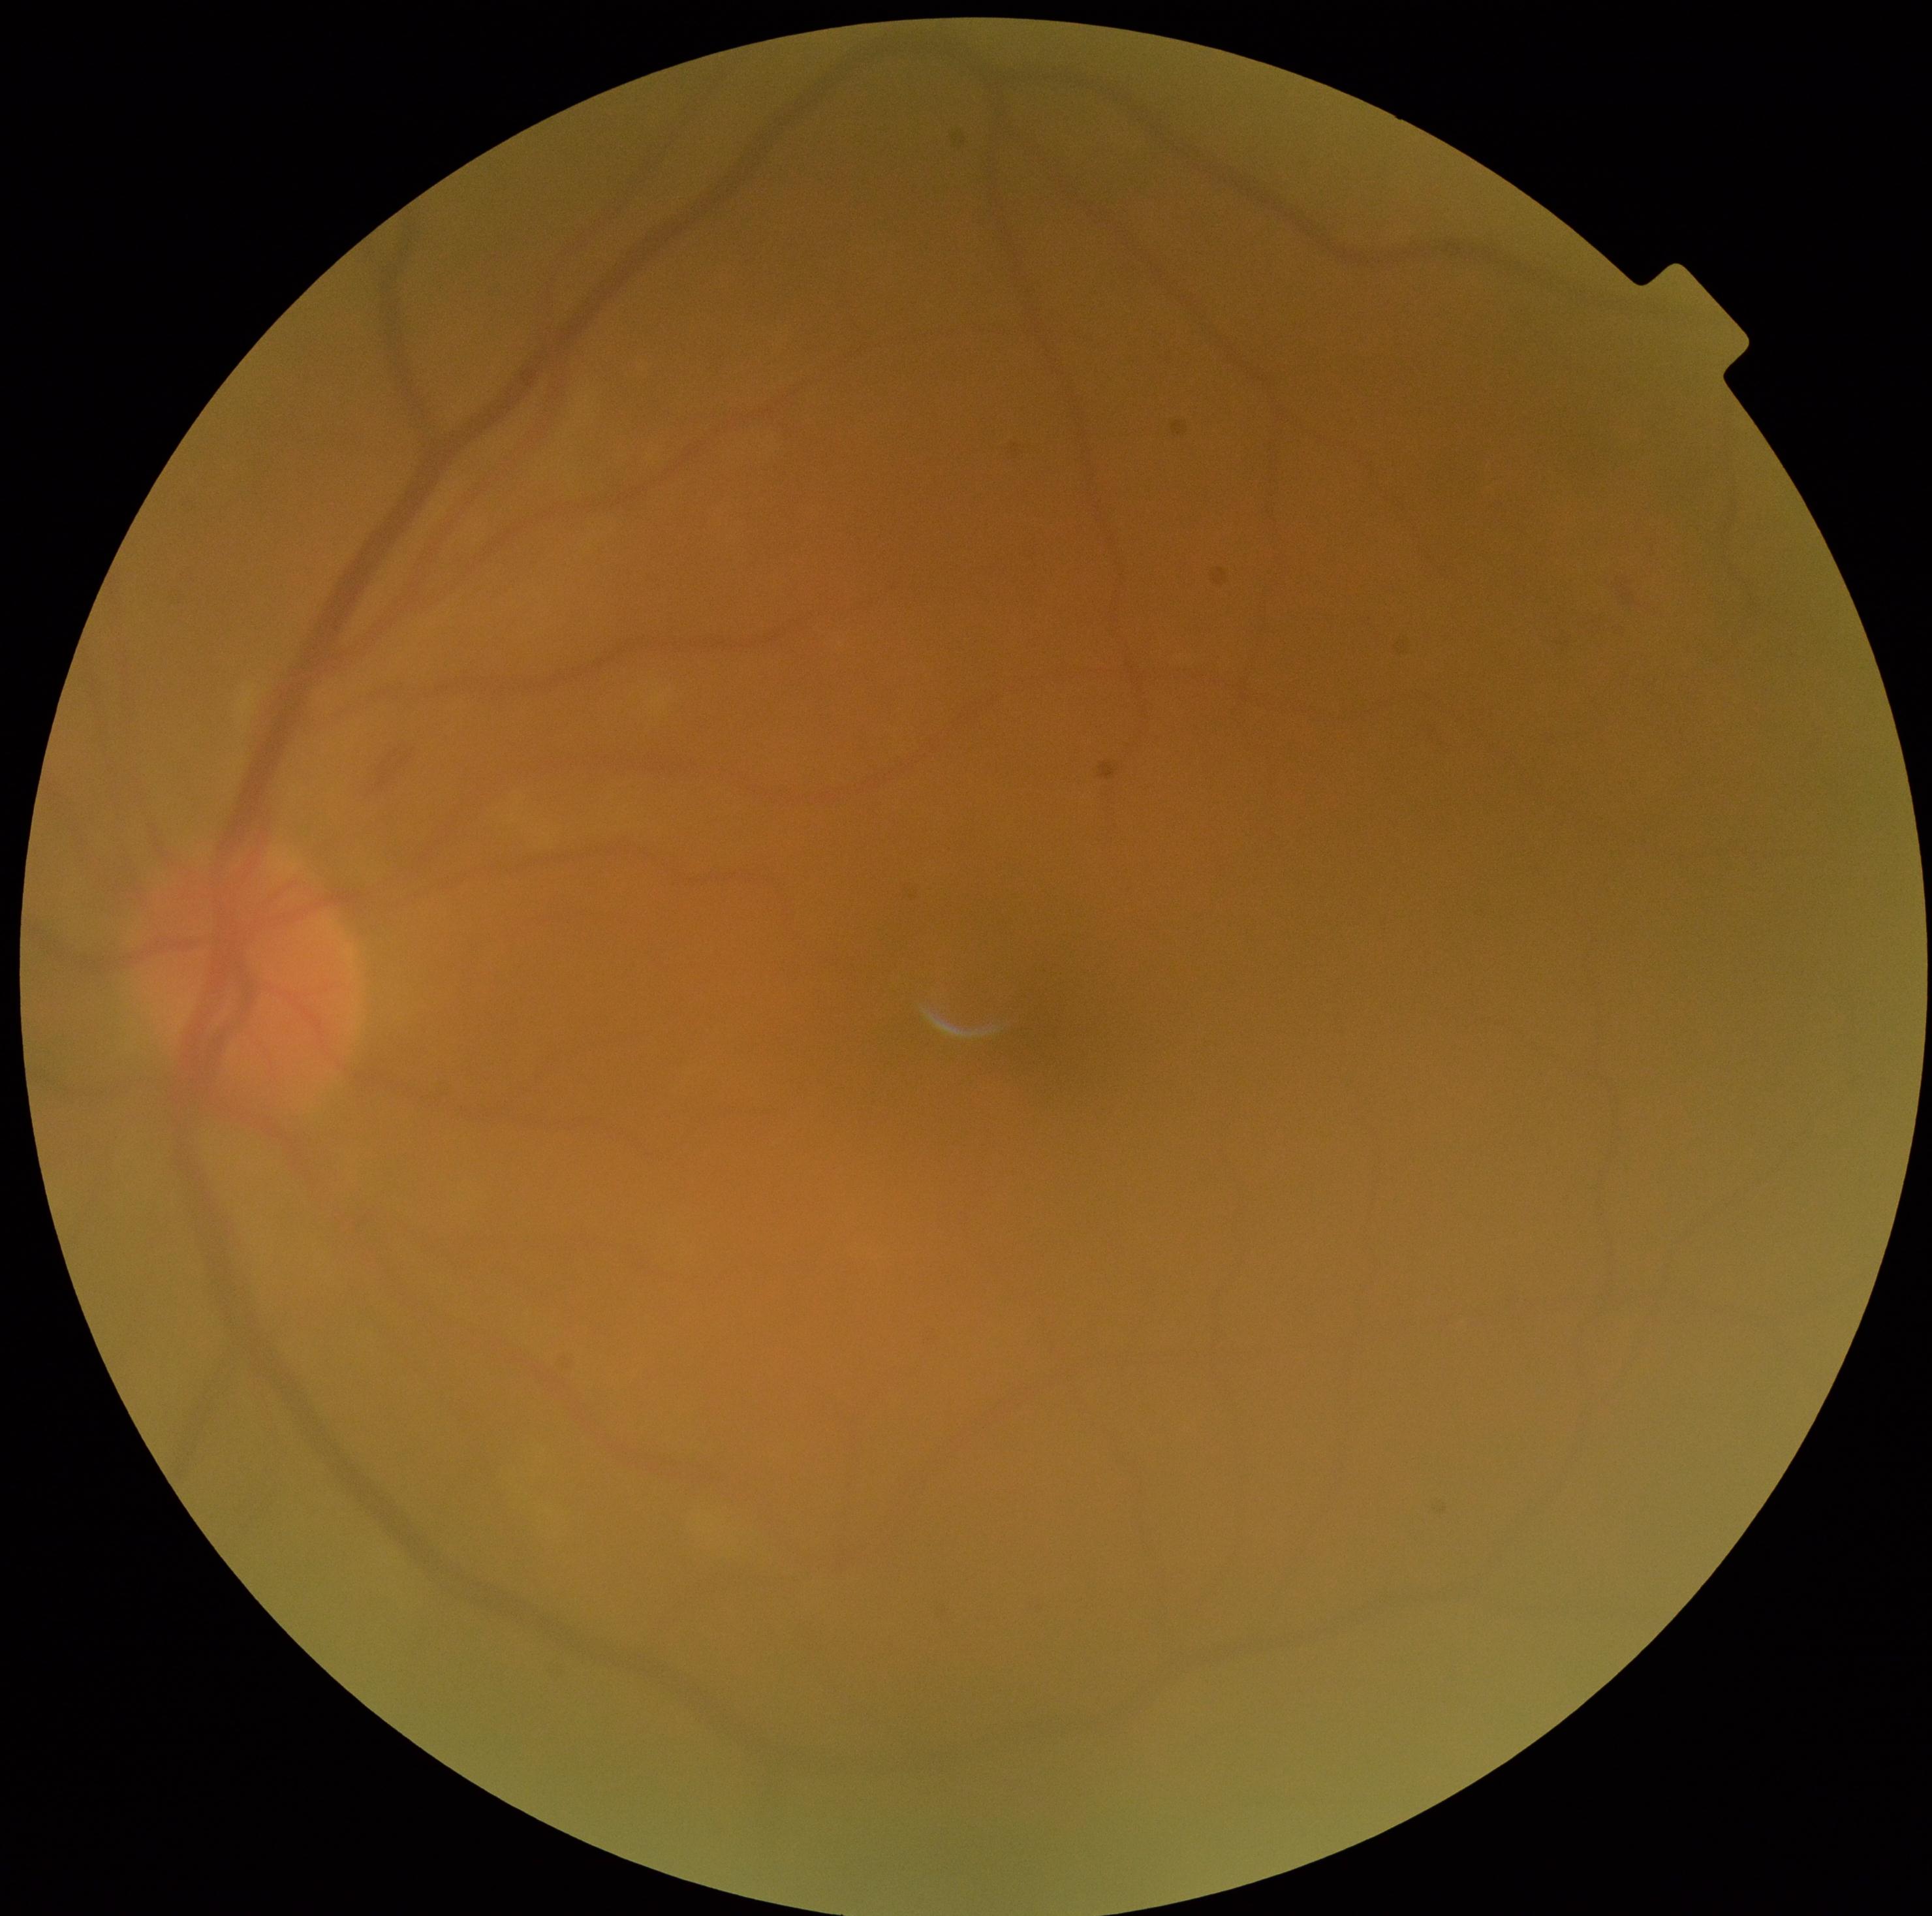 DR grade is 2 (moderate NPDR). The retinopathy is classified as non-proliferative diabetic retinopathy.